Color fundus photograph — 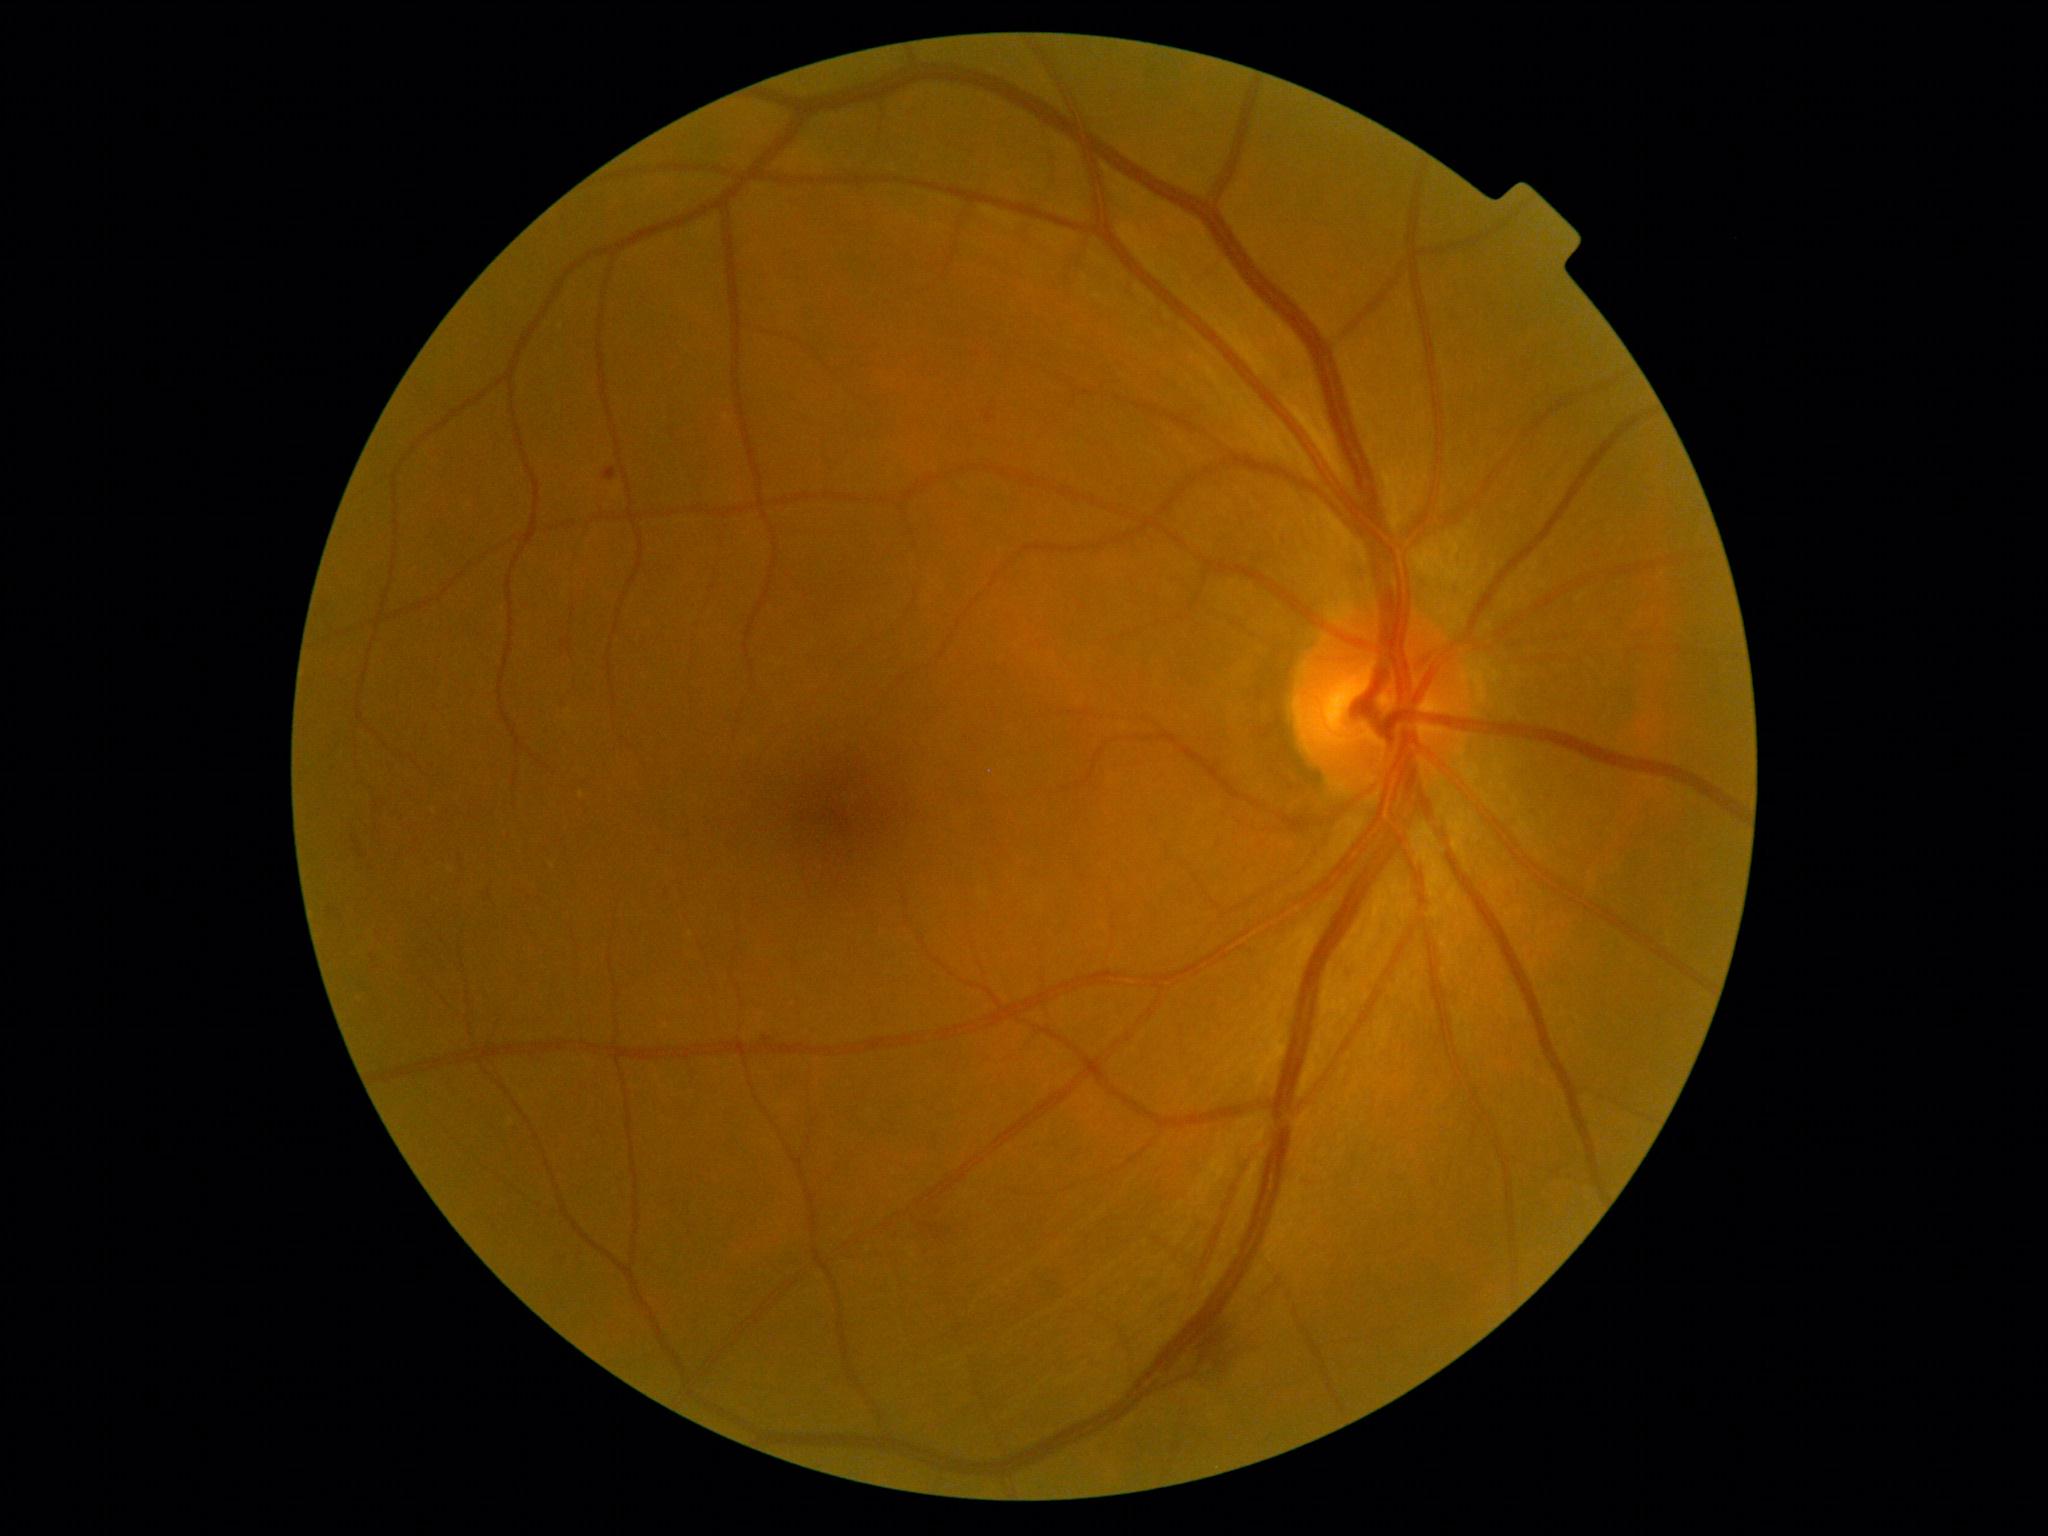 Disease class: non-proliferative diabetic retinopathy. DR severity is moderate NPDR (grade 2).